Davis DR grading.
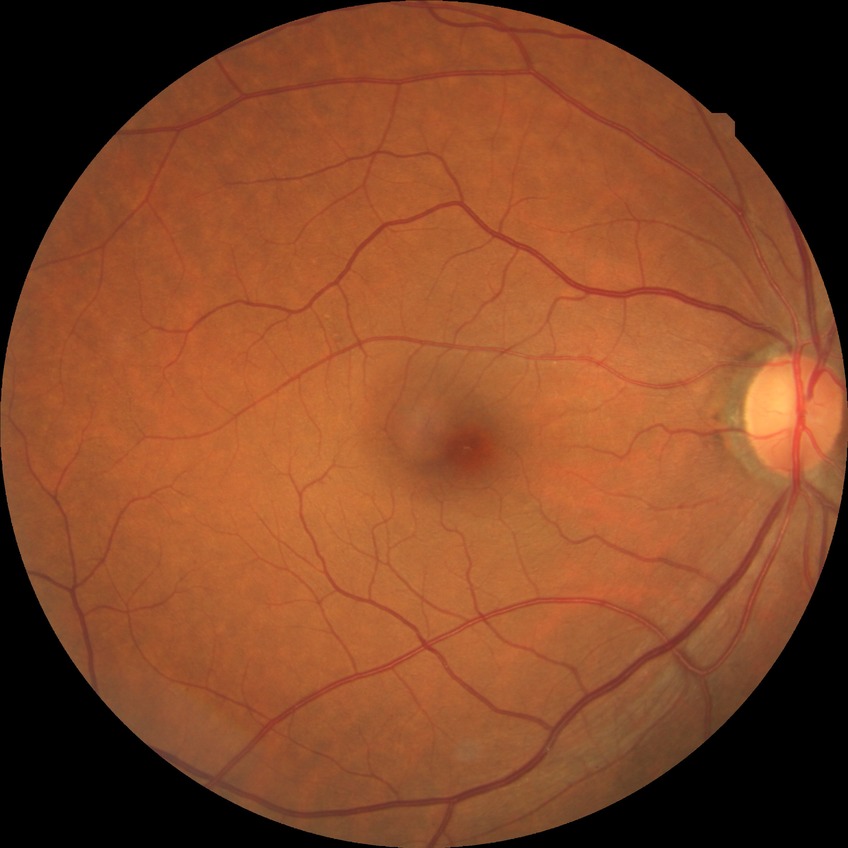 diabetic retinopathy (DR): no diabetic retinopathy (NDR).